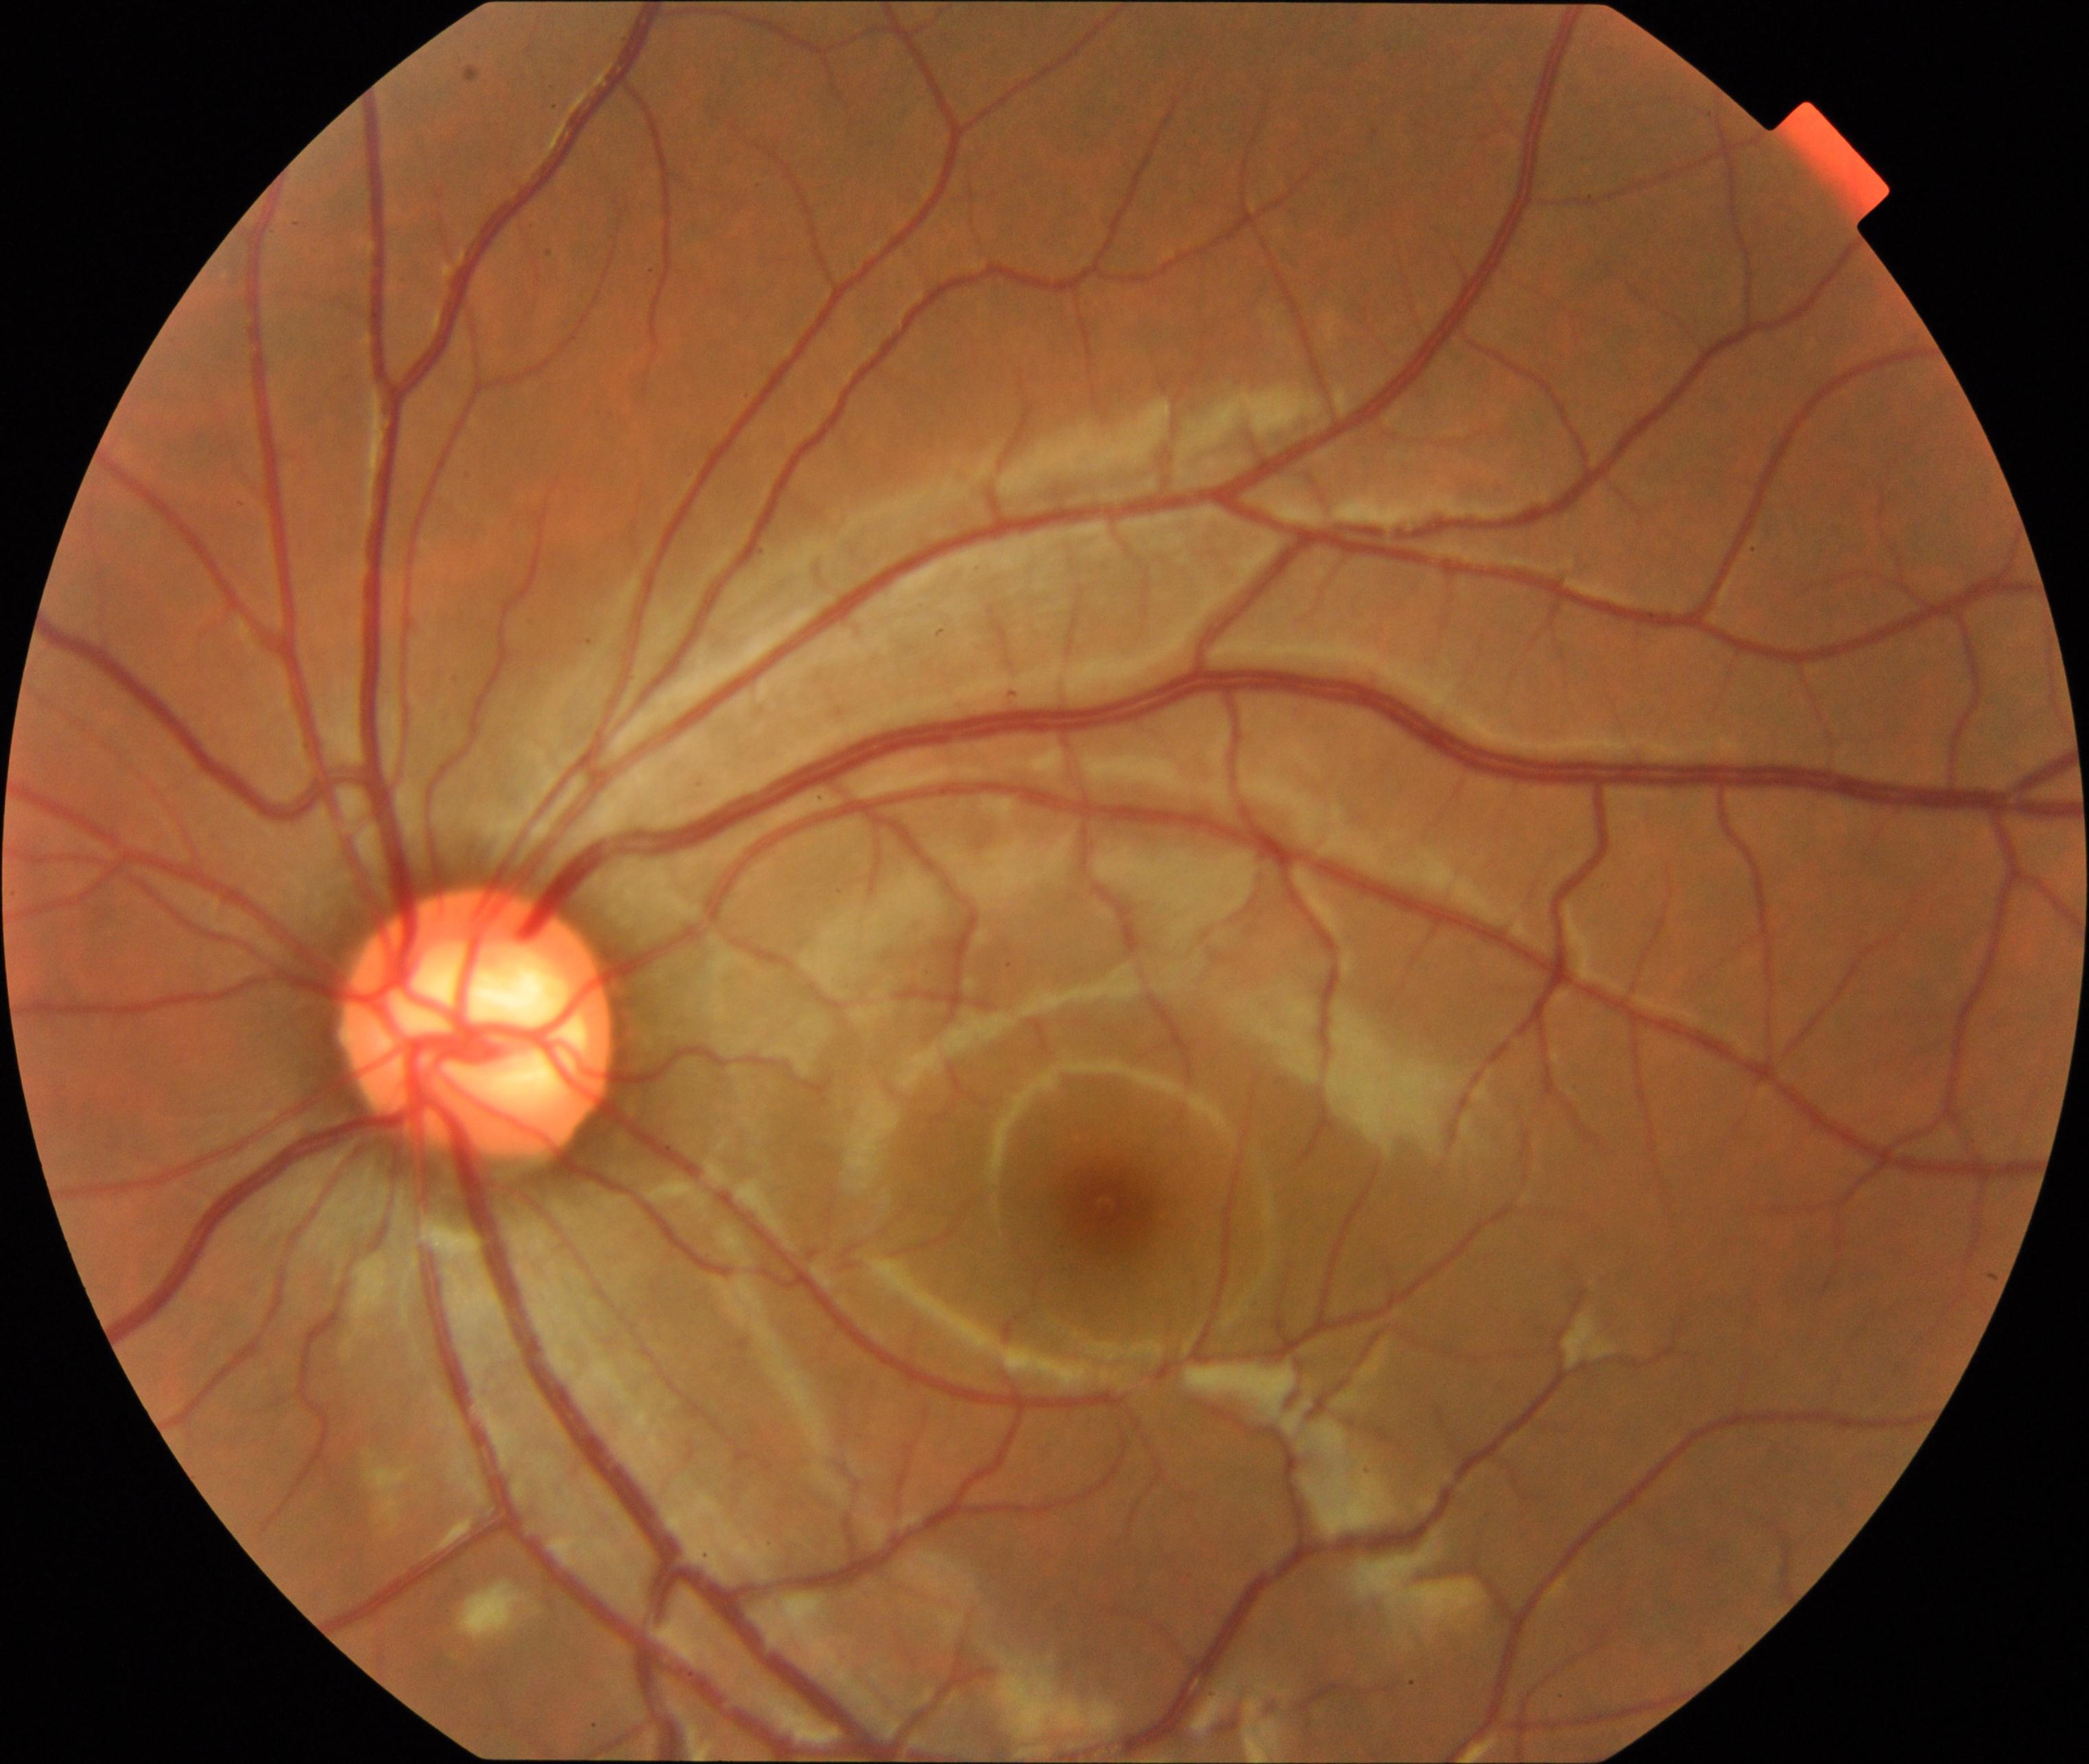
This fundus photograph shows large optic cup. Features include cup-to-disc ratio greater than 0.5, with a pink neuroretinal rim following the ISNT rule, without notching or bayoneting of vessels.